No pharmacologic dilation. 45° FOV. 848x848px: 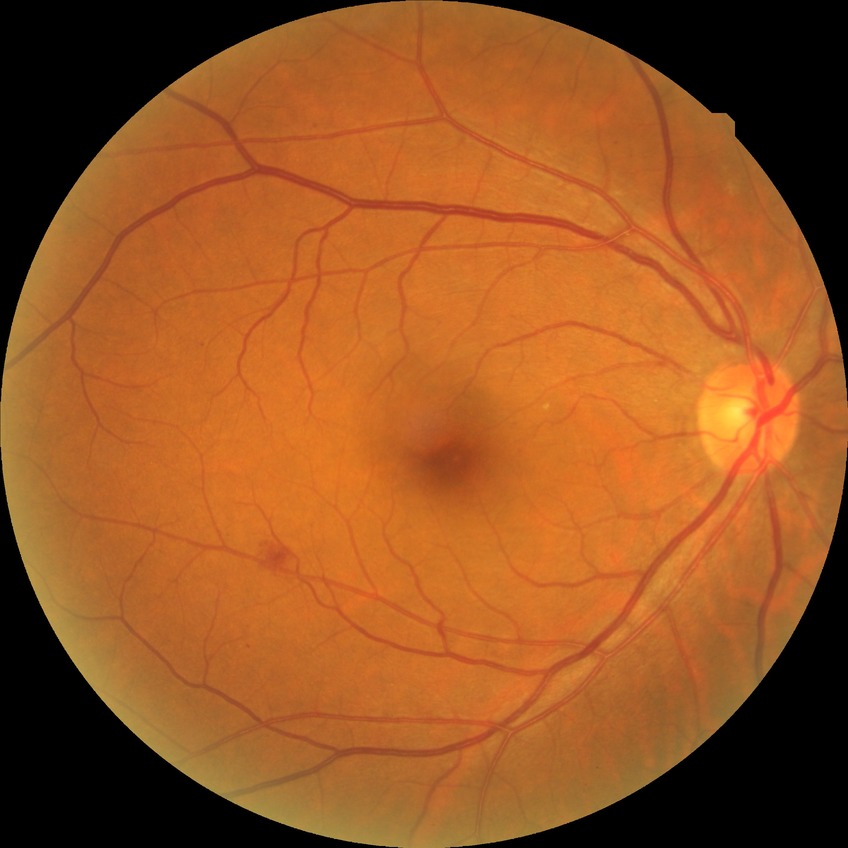
Retinopathy stage: simple diabetic retinopathy.